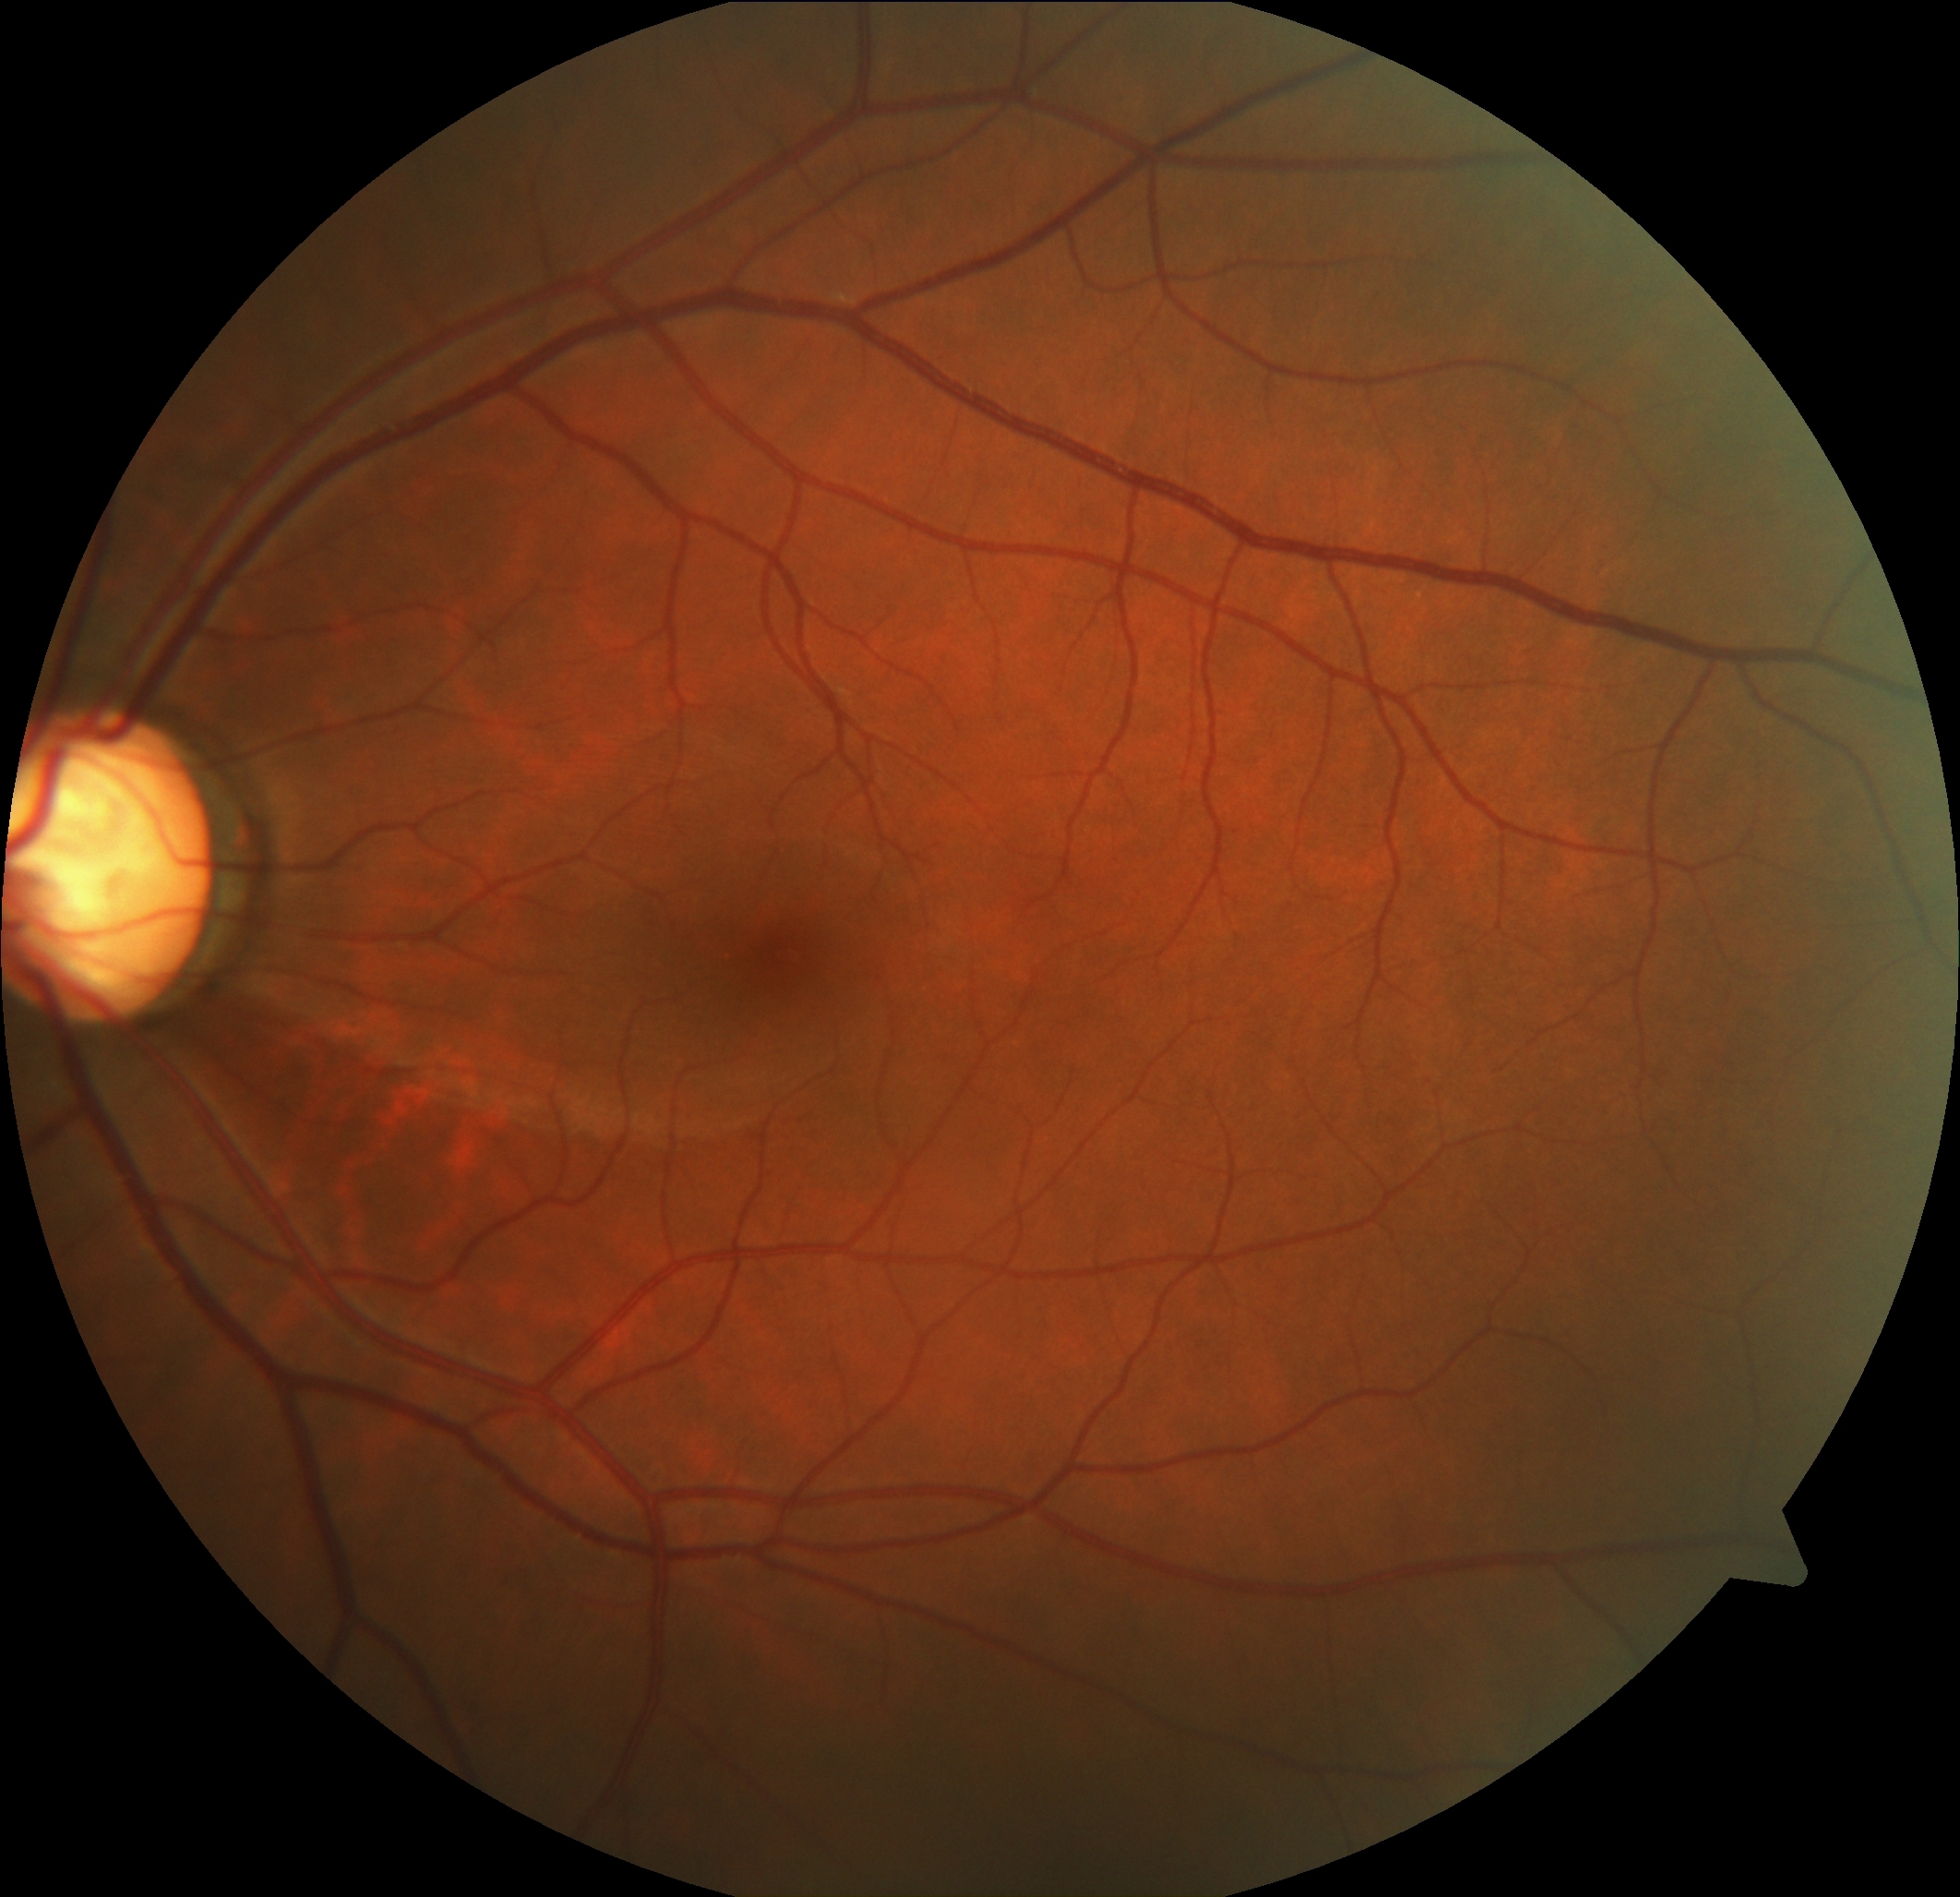 diabetic retinopathy grade = 0 (no apparent retinopathy)
DR impression = no signs of DR